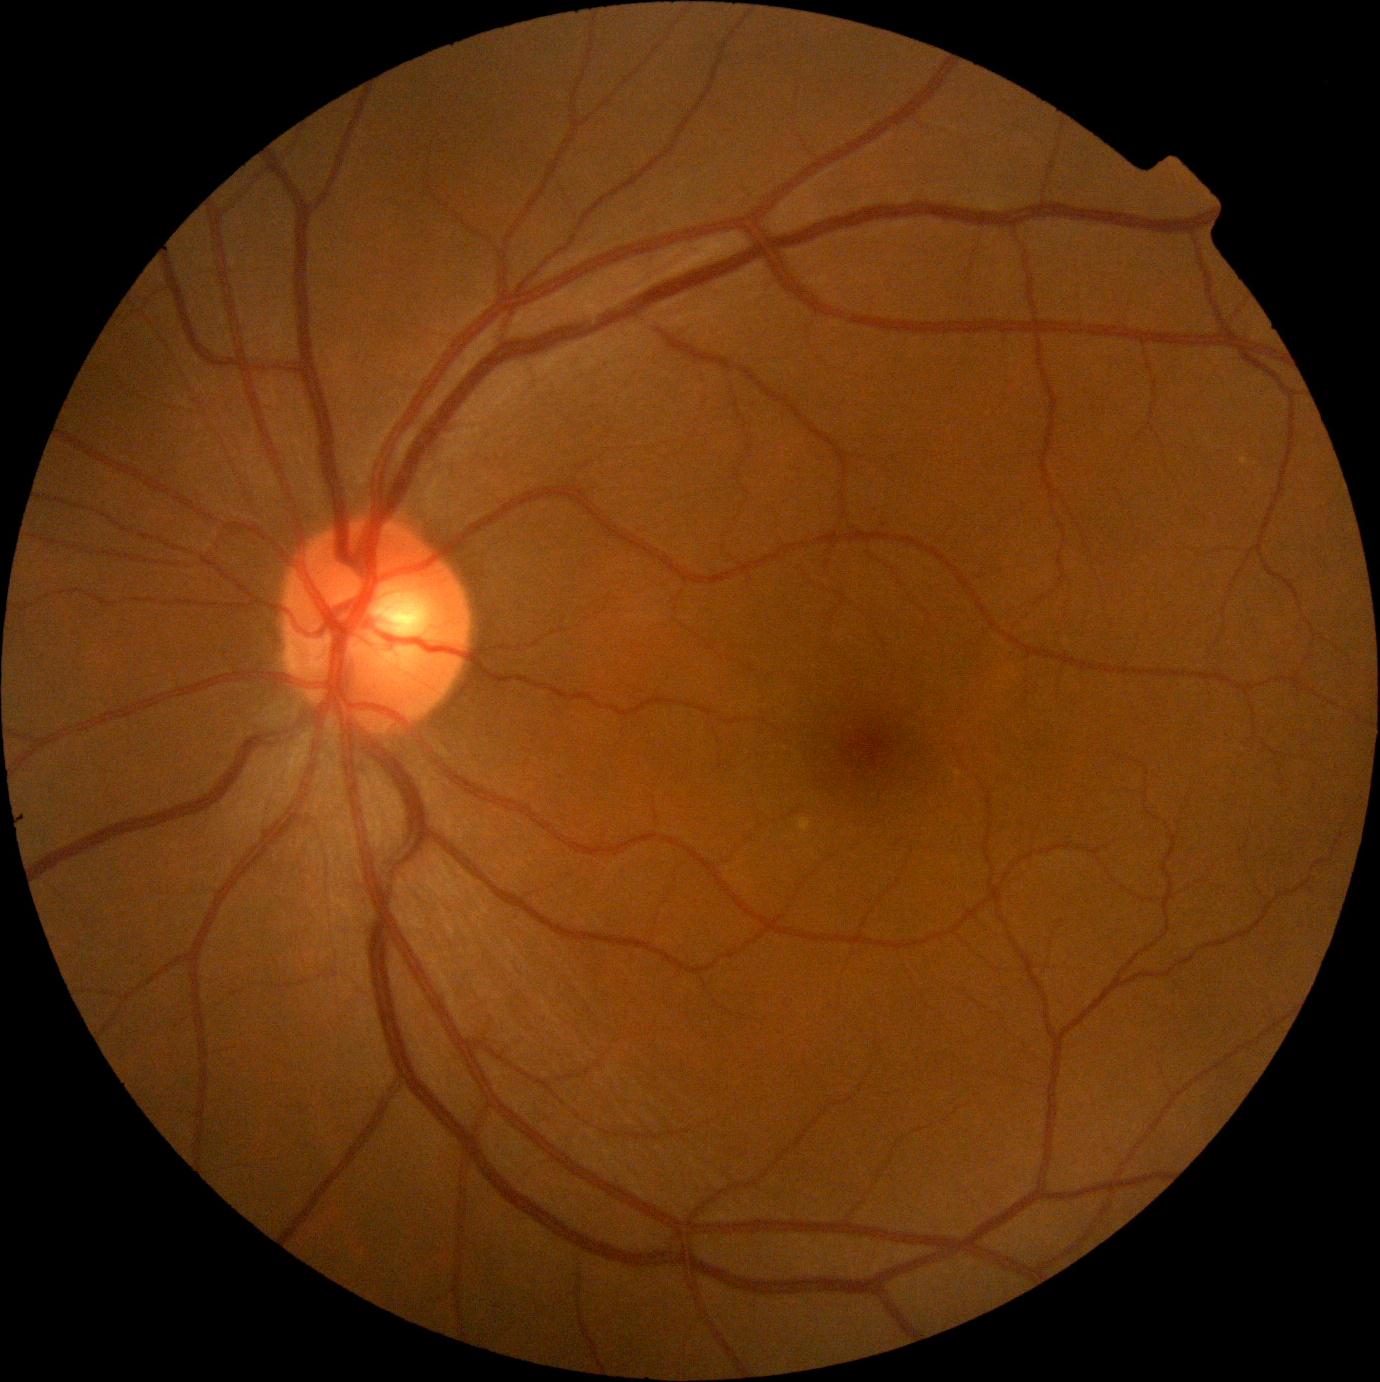
DR stage is 0/4.